Fundus photo:
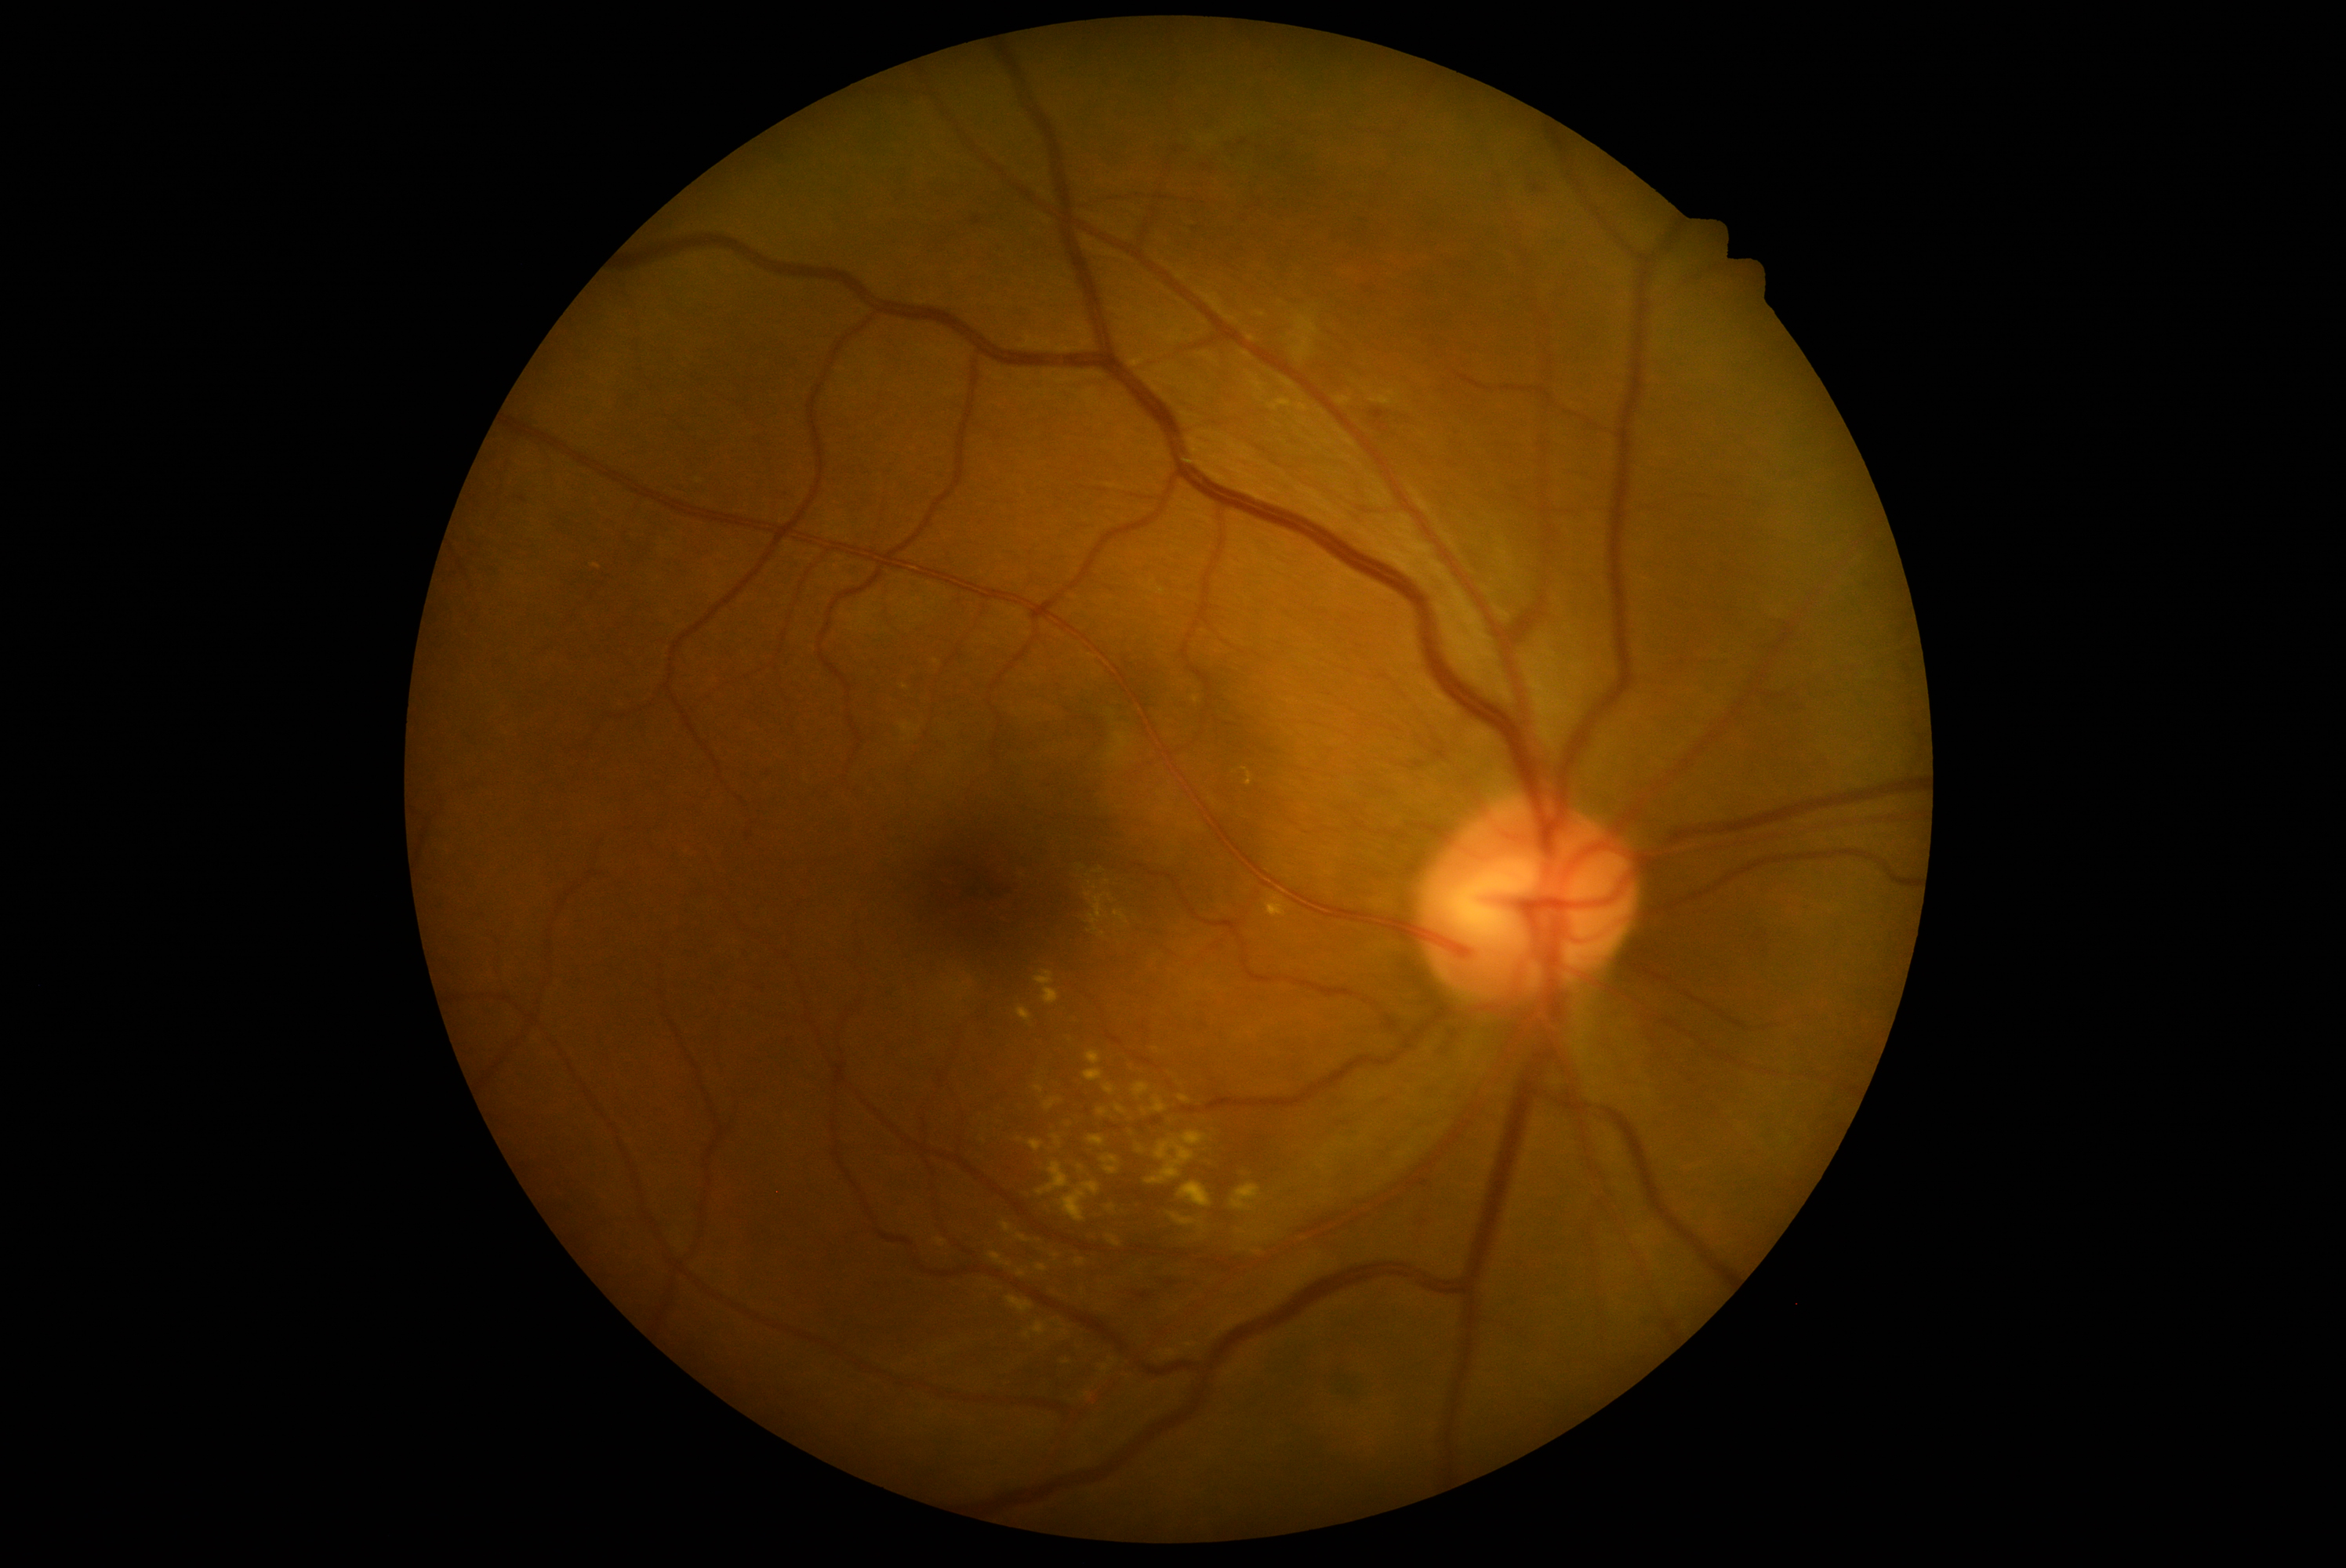 {"partial":true,"dr_grade":2,"dr_grade_name":"moderate NPDR","lesions":{"ex":[[1105,1084,1117,1095],[1230,1185,1262,1213],[1036,1265,1048,1272],[1280,399,1290,405],[1097,1109,1108,1116],[1254,1233,1262,1240],[1034,1086,1045,1094],[1243,768,1252,786],[1061,1181,1100,1222],[1133,1083,1150,1097],[1102,1155,1119,1175],[1089,1136,1106,1149],[1199,1222,1204,1230]],"ex_small_approx":[[1095,888],[1141,1151],[1066,1363],[1099,871]]}}